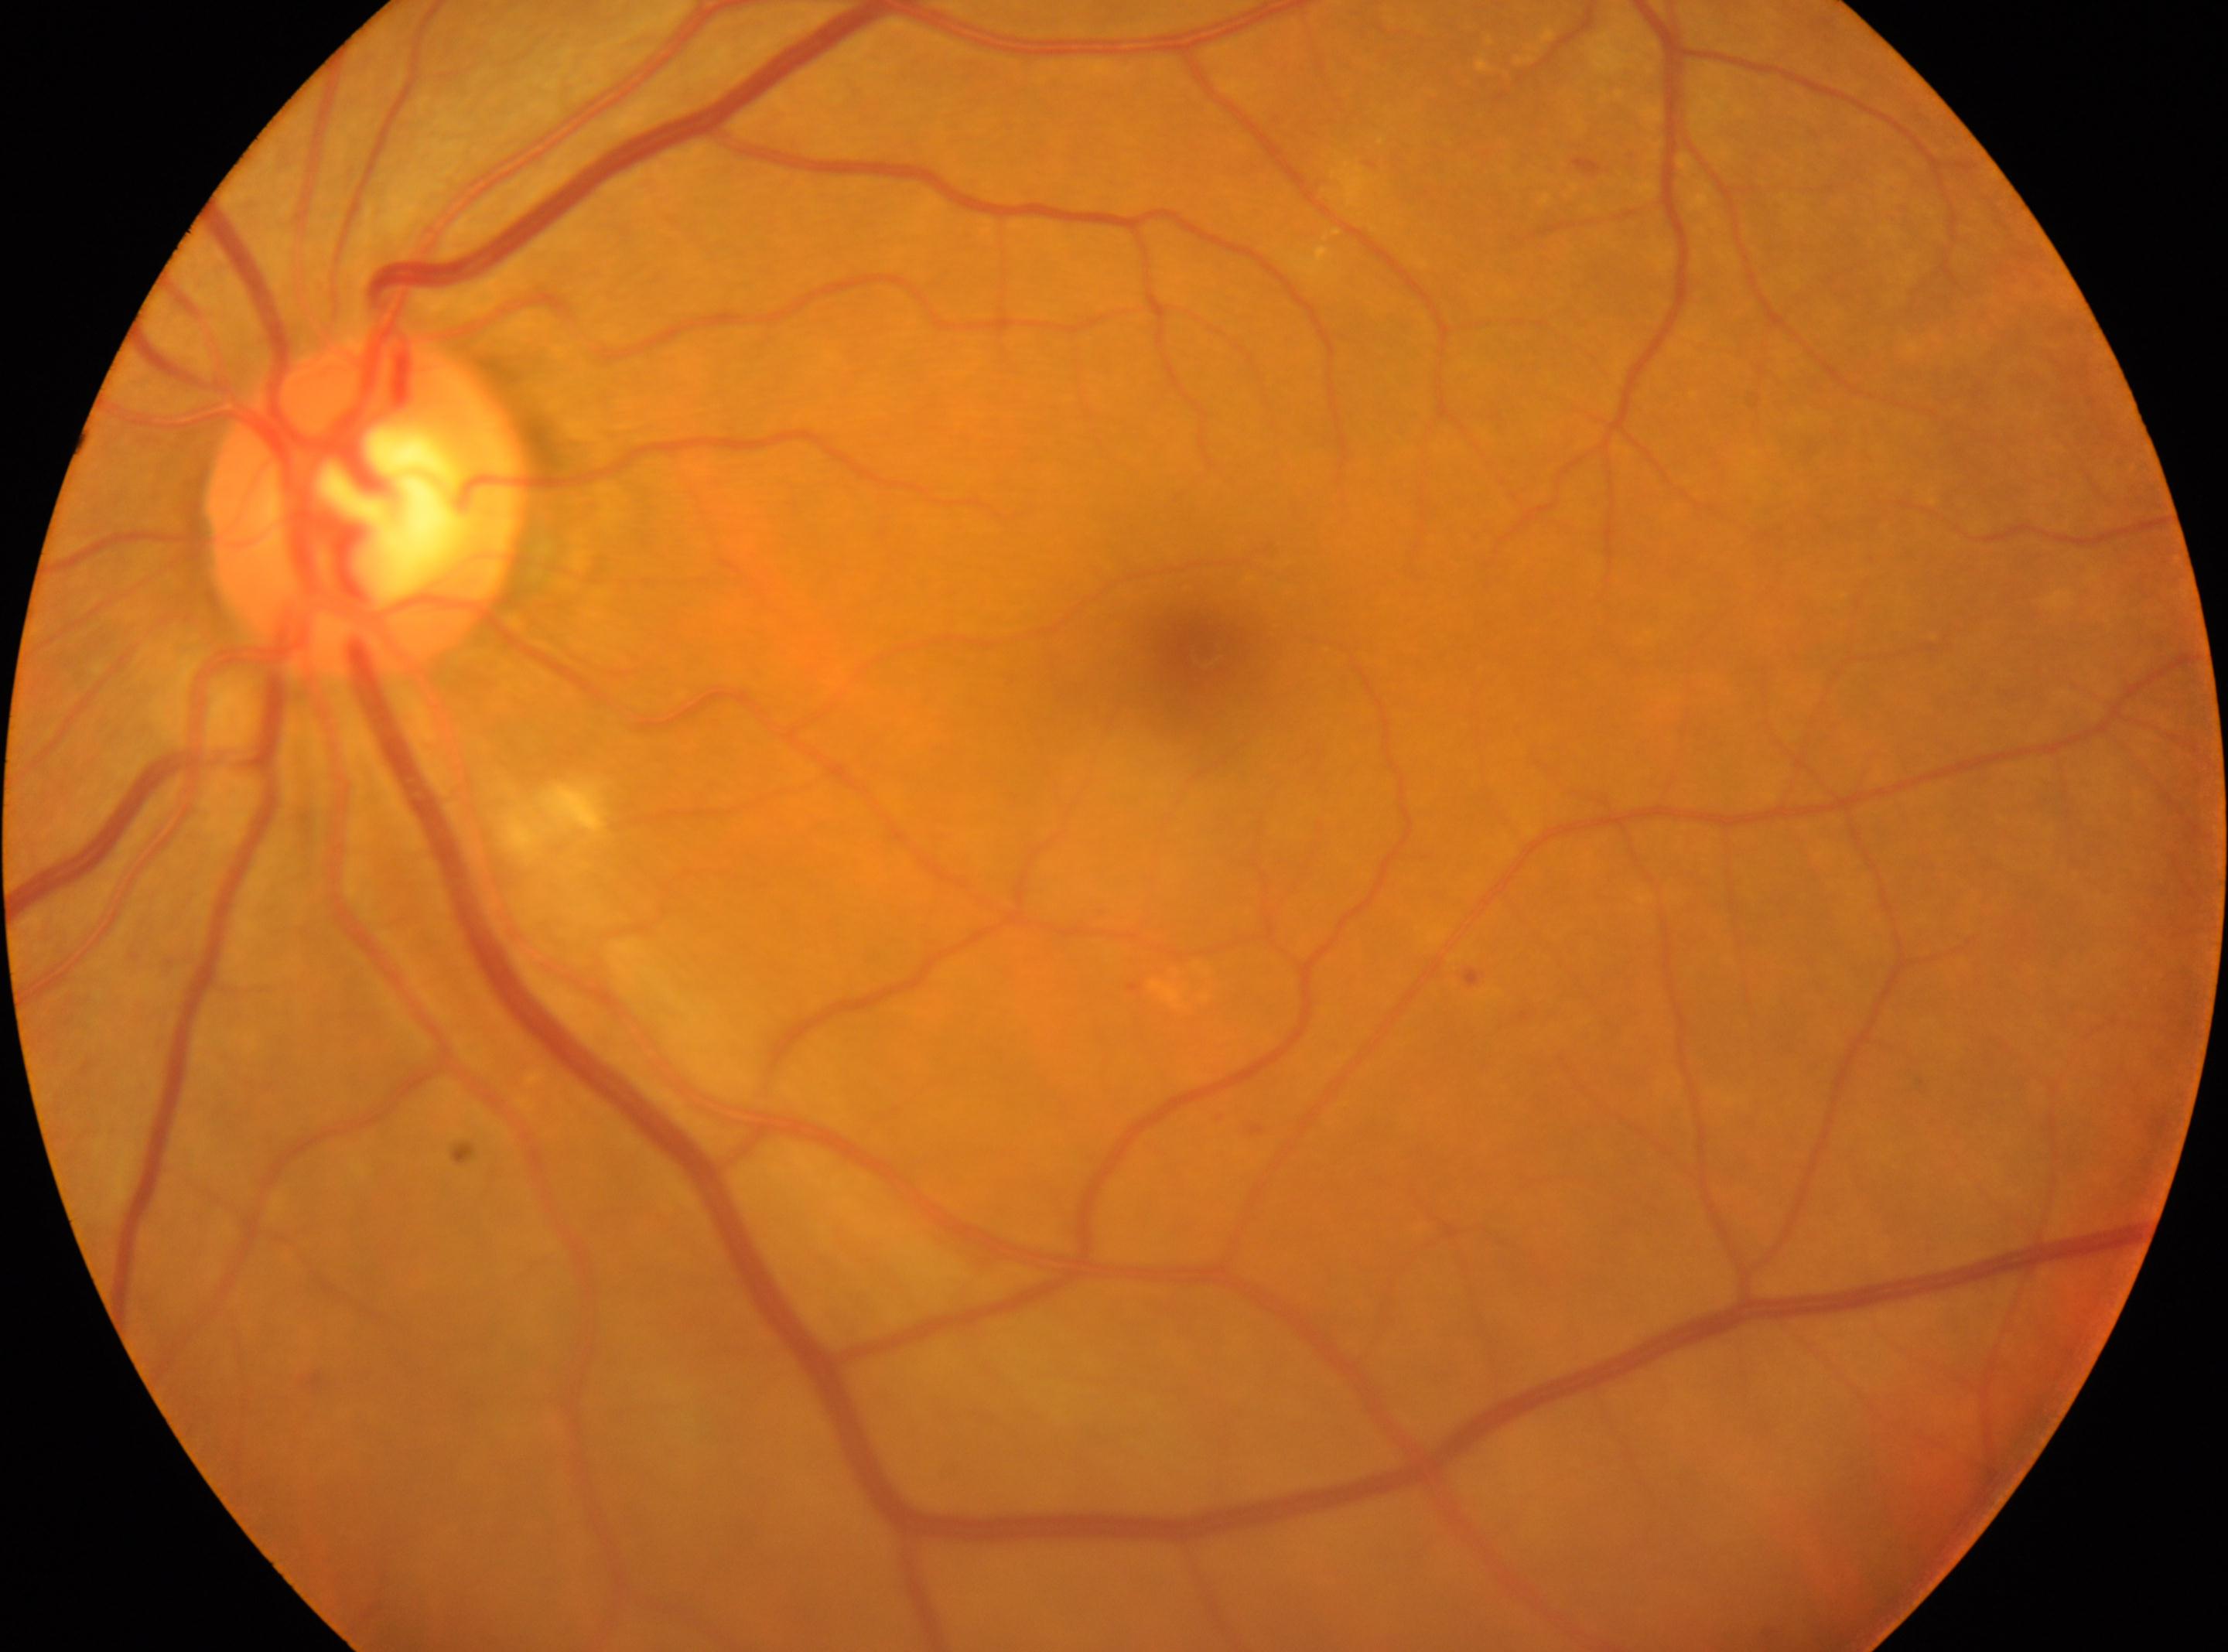

Q: Locate the fovea.
A: x=1208, y=653
Q: What is the laterality?
A: oculus sinister
Q: What disease class is present?
A: non-proliferative diabetic retinopathy
Q: DR stage?
A: 2 — more than just microaneurysms but less than severe NPDR
Q: Locate the optic disc.
A: x=364, y=506